640 by 480 pixels; wide-field contact fundus photograph of an infant: 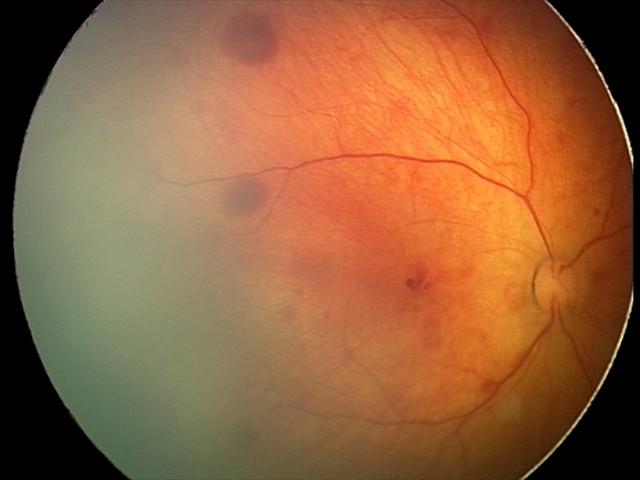

From an examination with diagnosis of retinal hemorrhages.